Acquired with a NIDEK AFC-230; 45° FOV; image size 848x848; nonmydriatic fundus photograph:
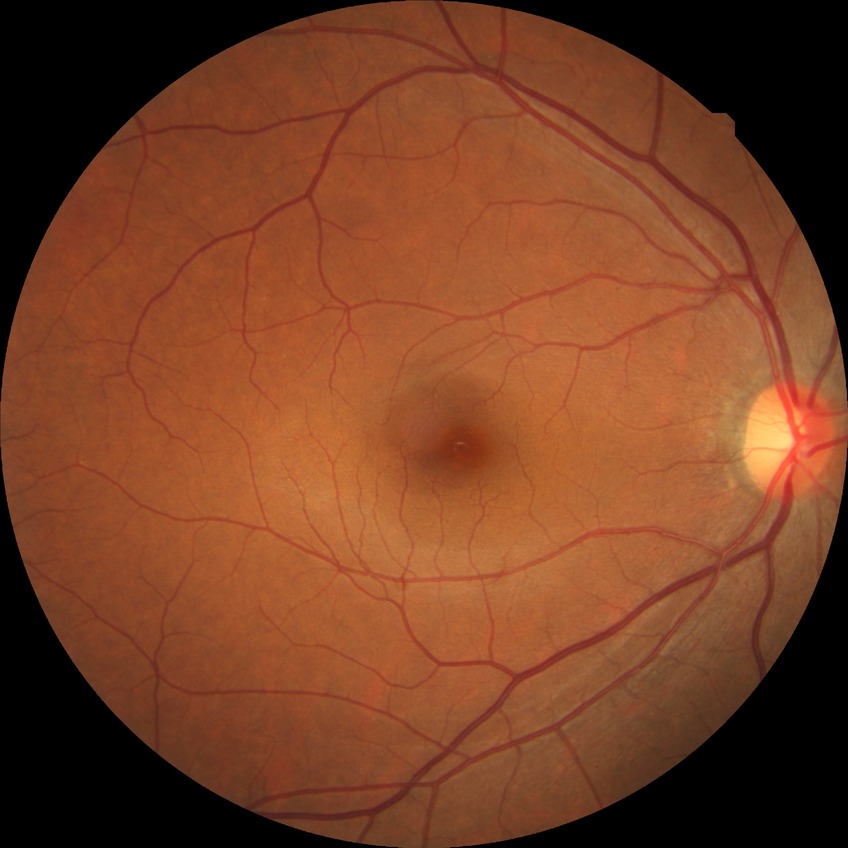 diabetic retinopathy (DR): no diabetic retinopathy (NDR).